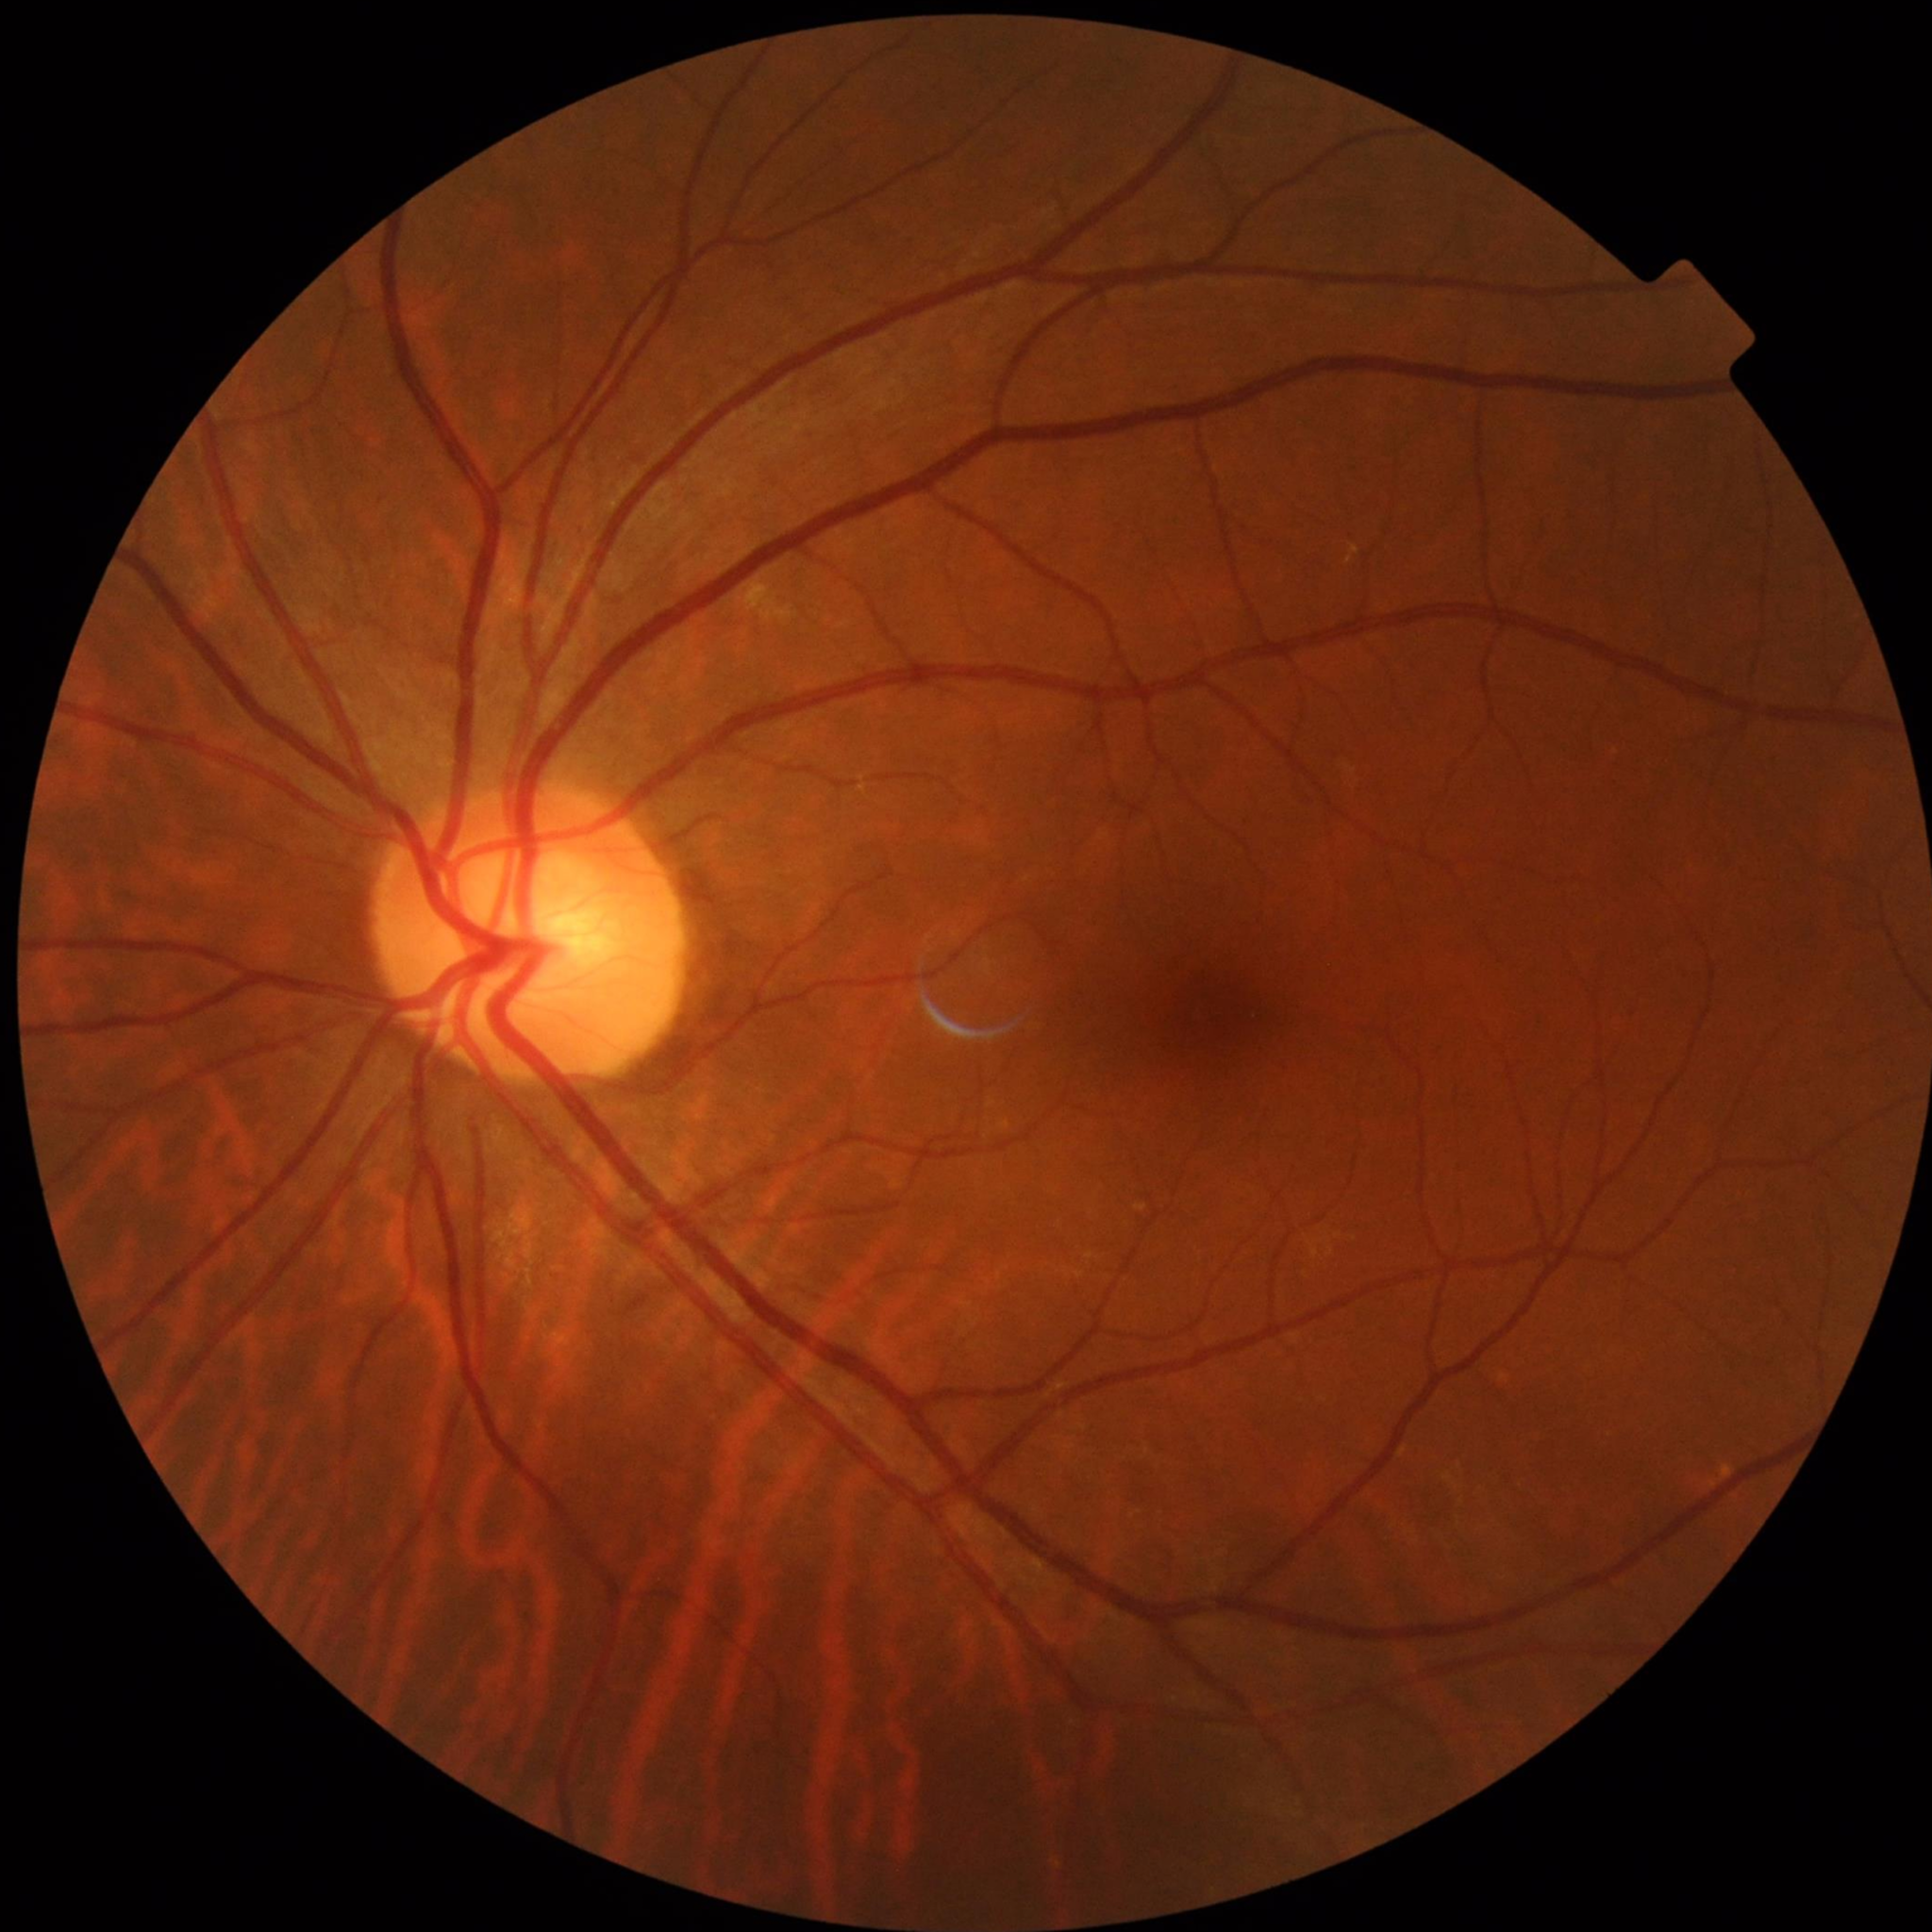

Color fundus photo from a control patient without diagnosed retinal disease.